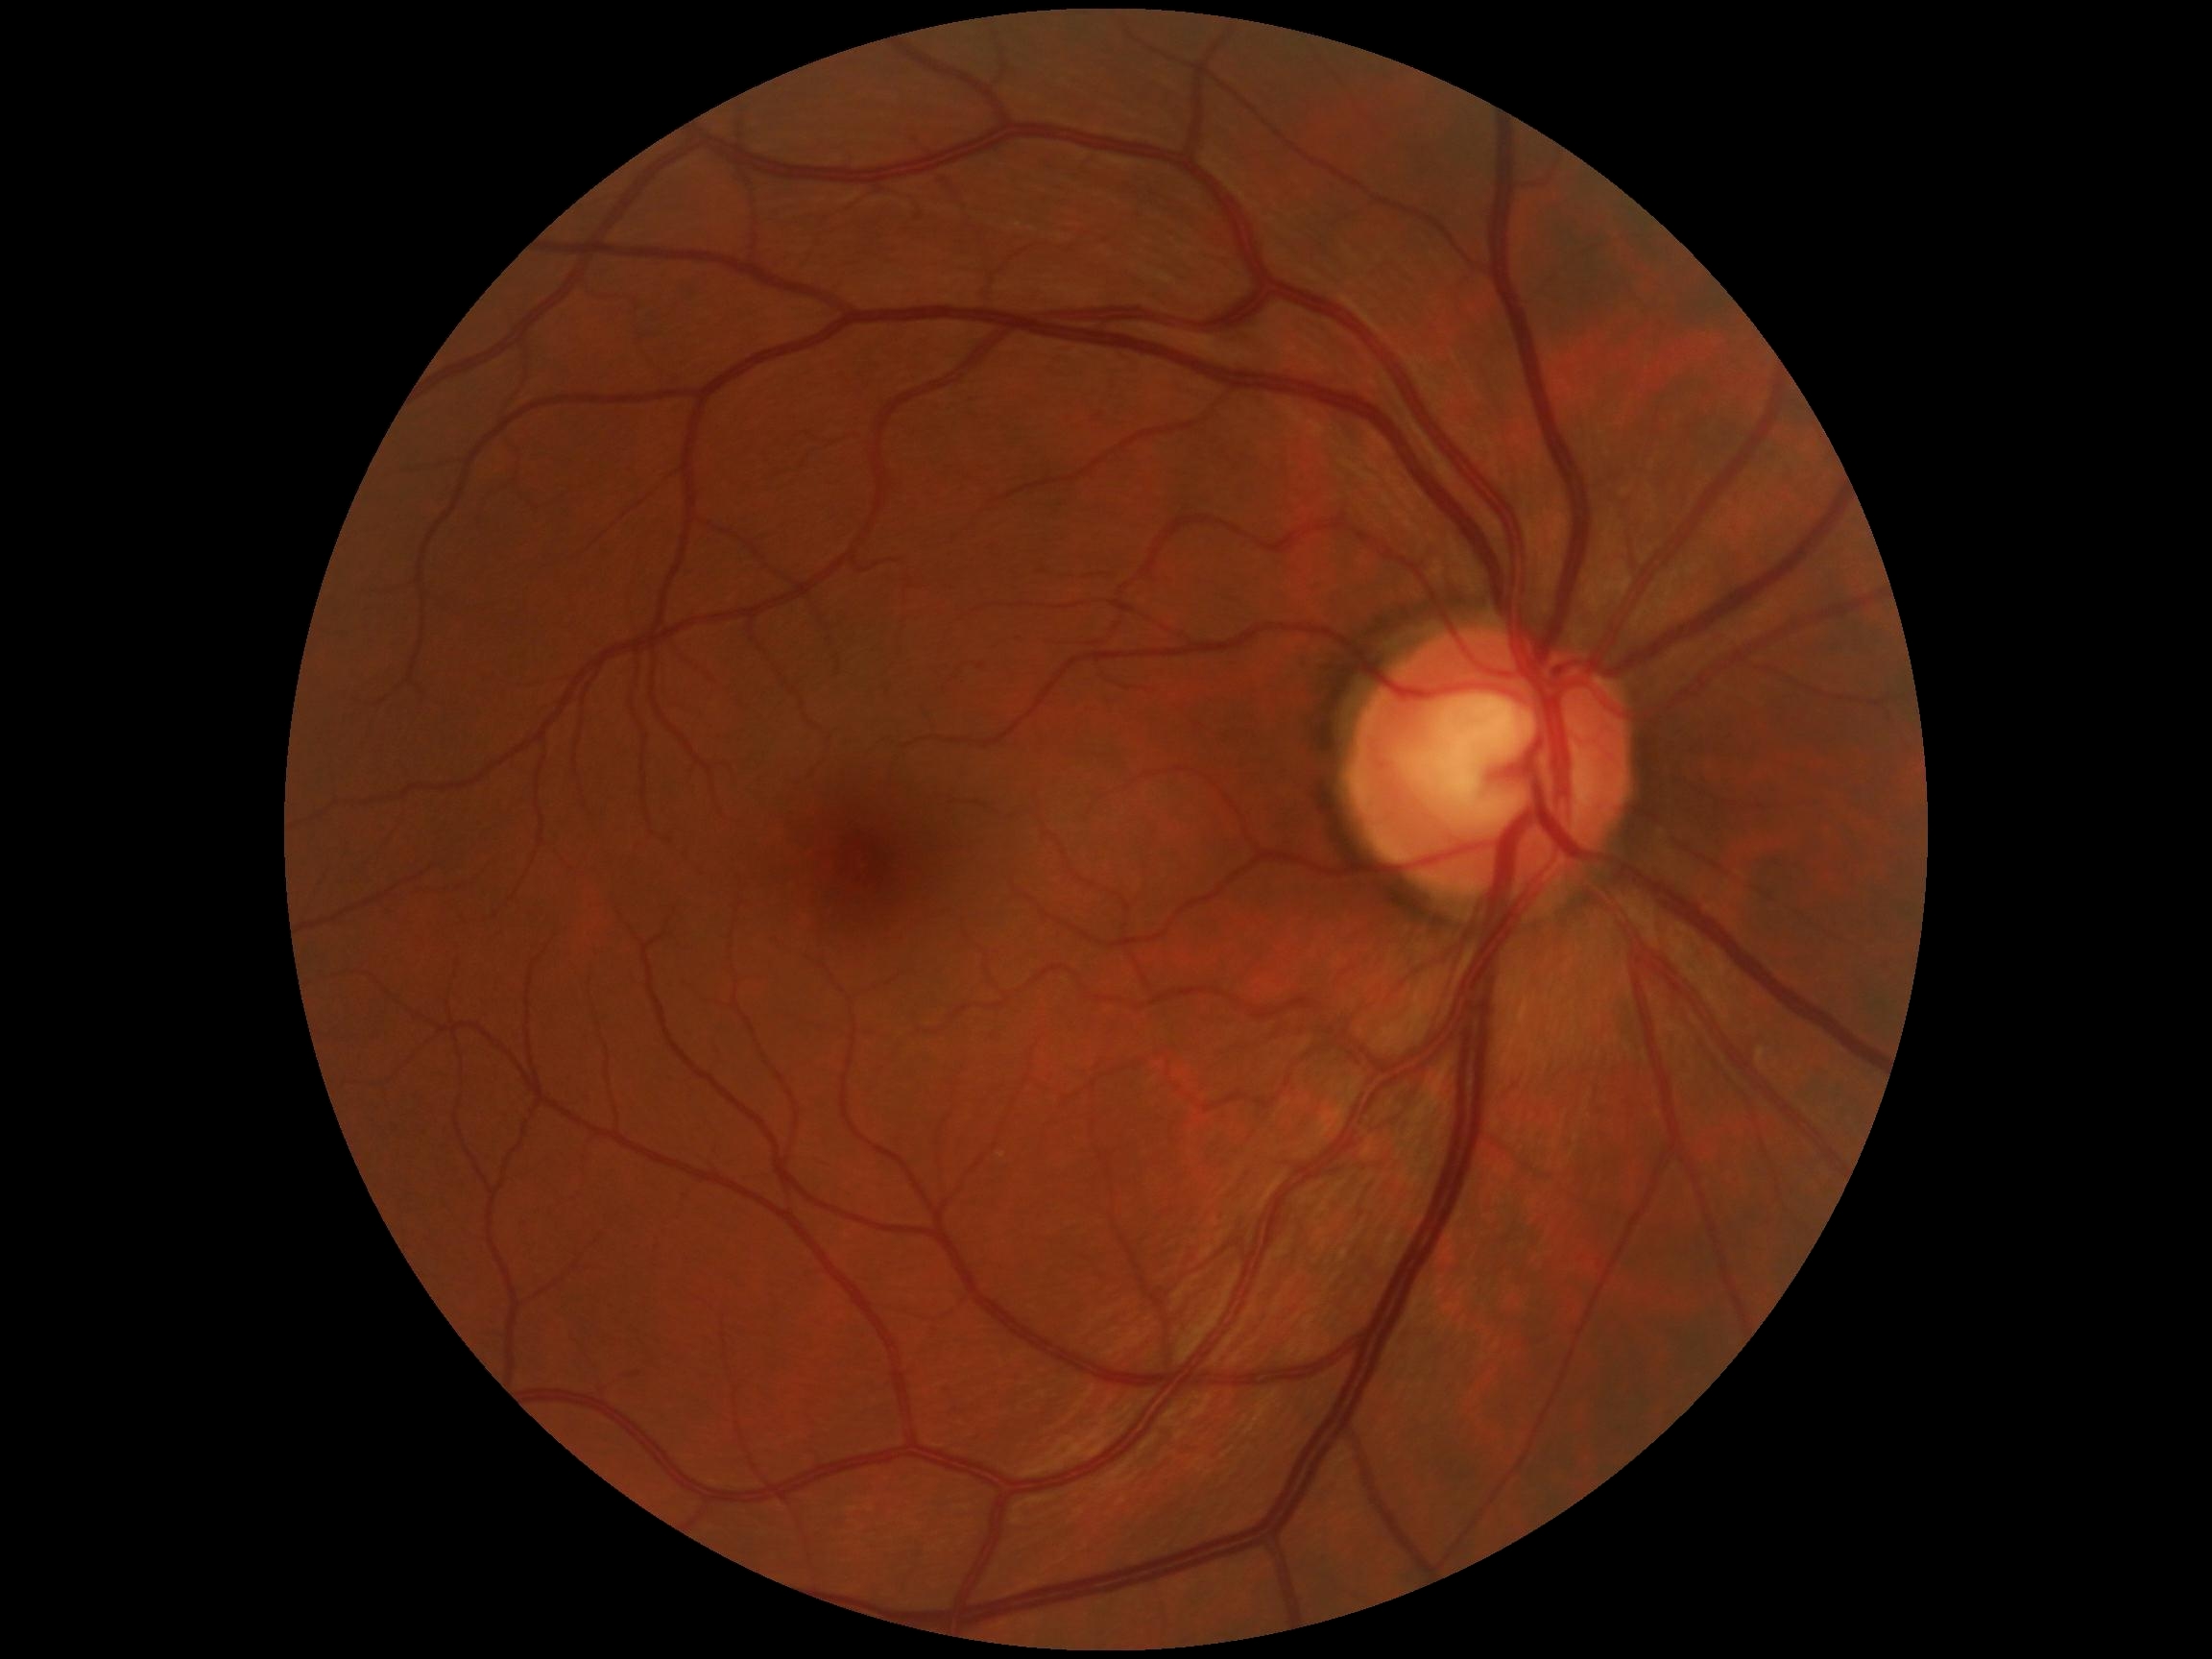
DR stage is grade 0 (no apparent retinopathy).